FOV: 50 degrees, macula-centered field.
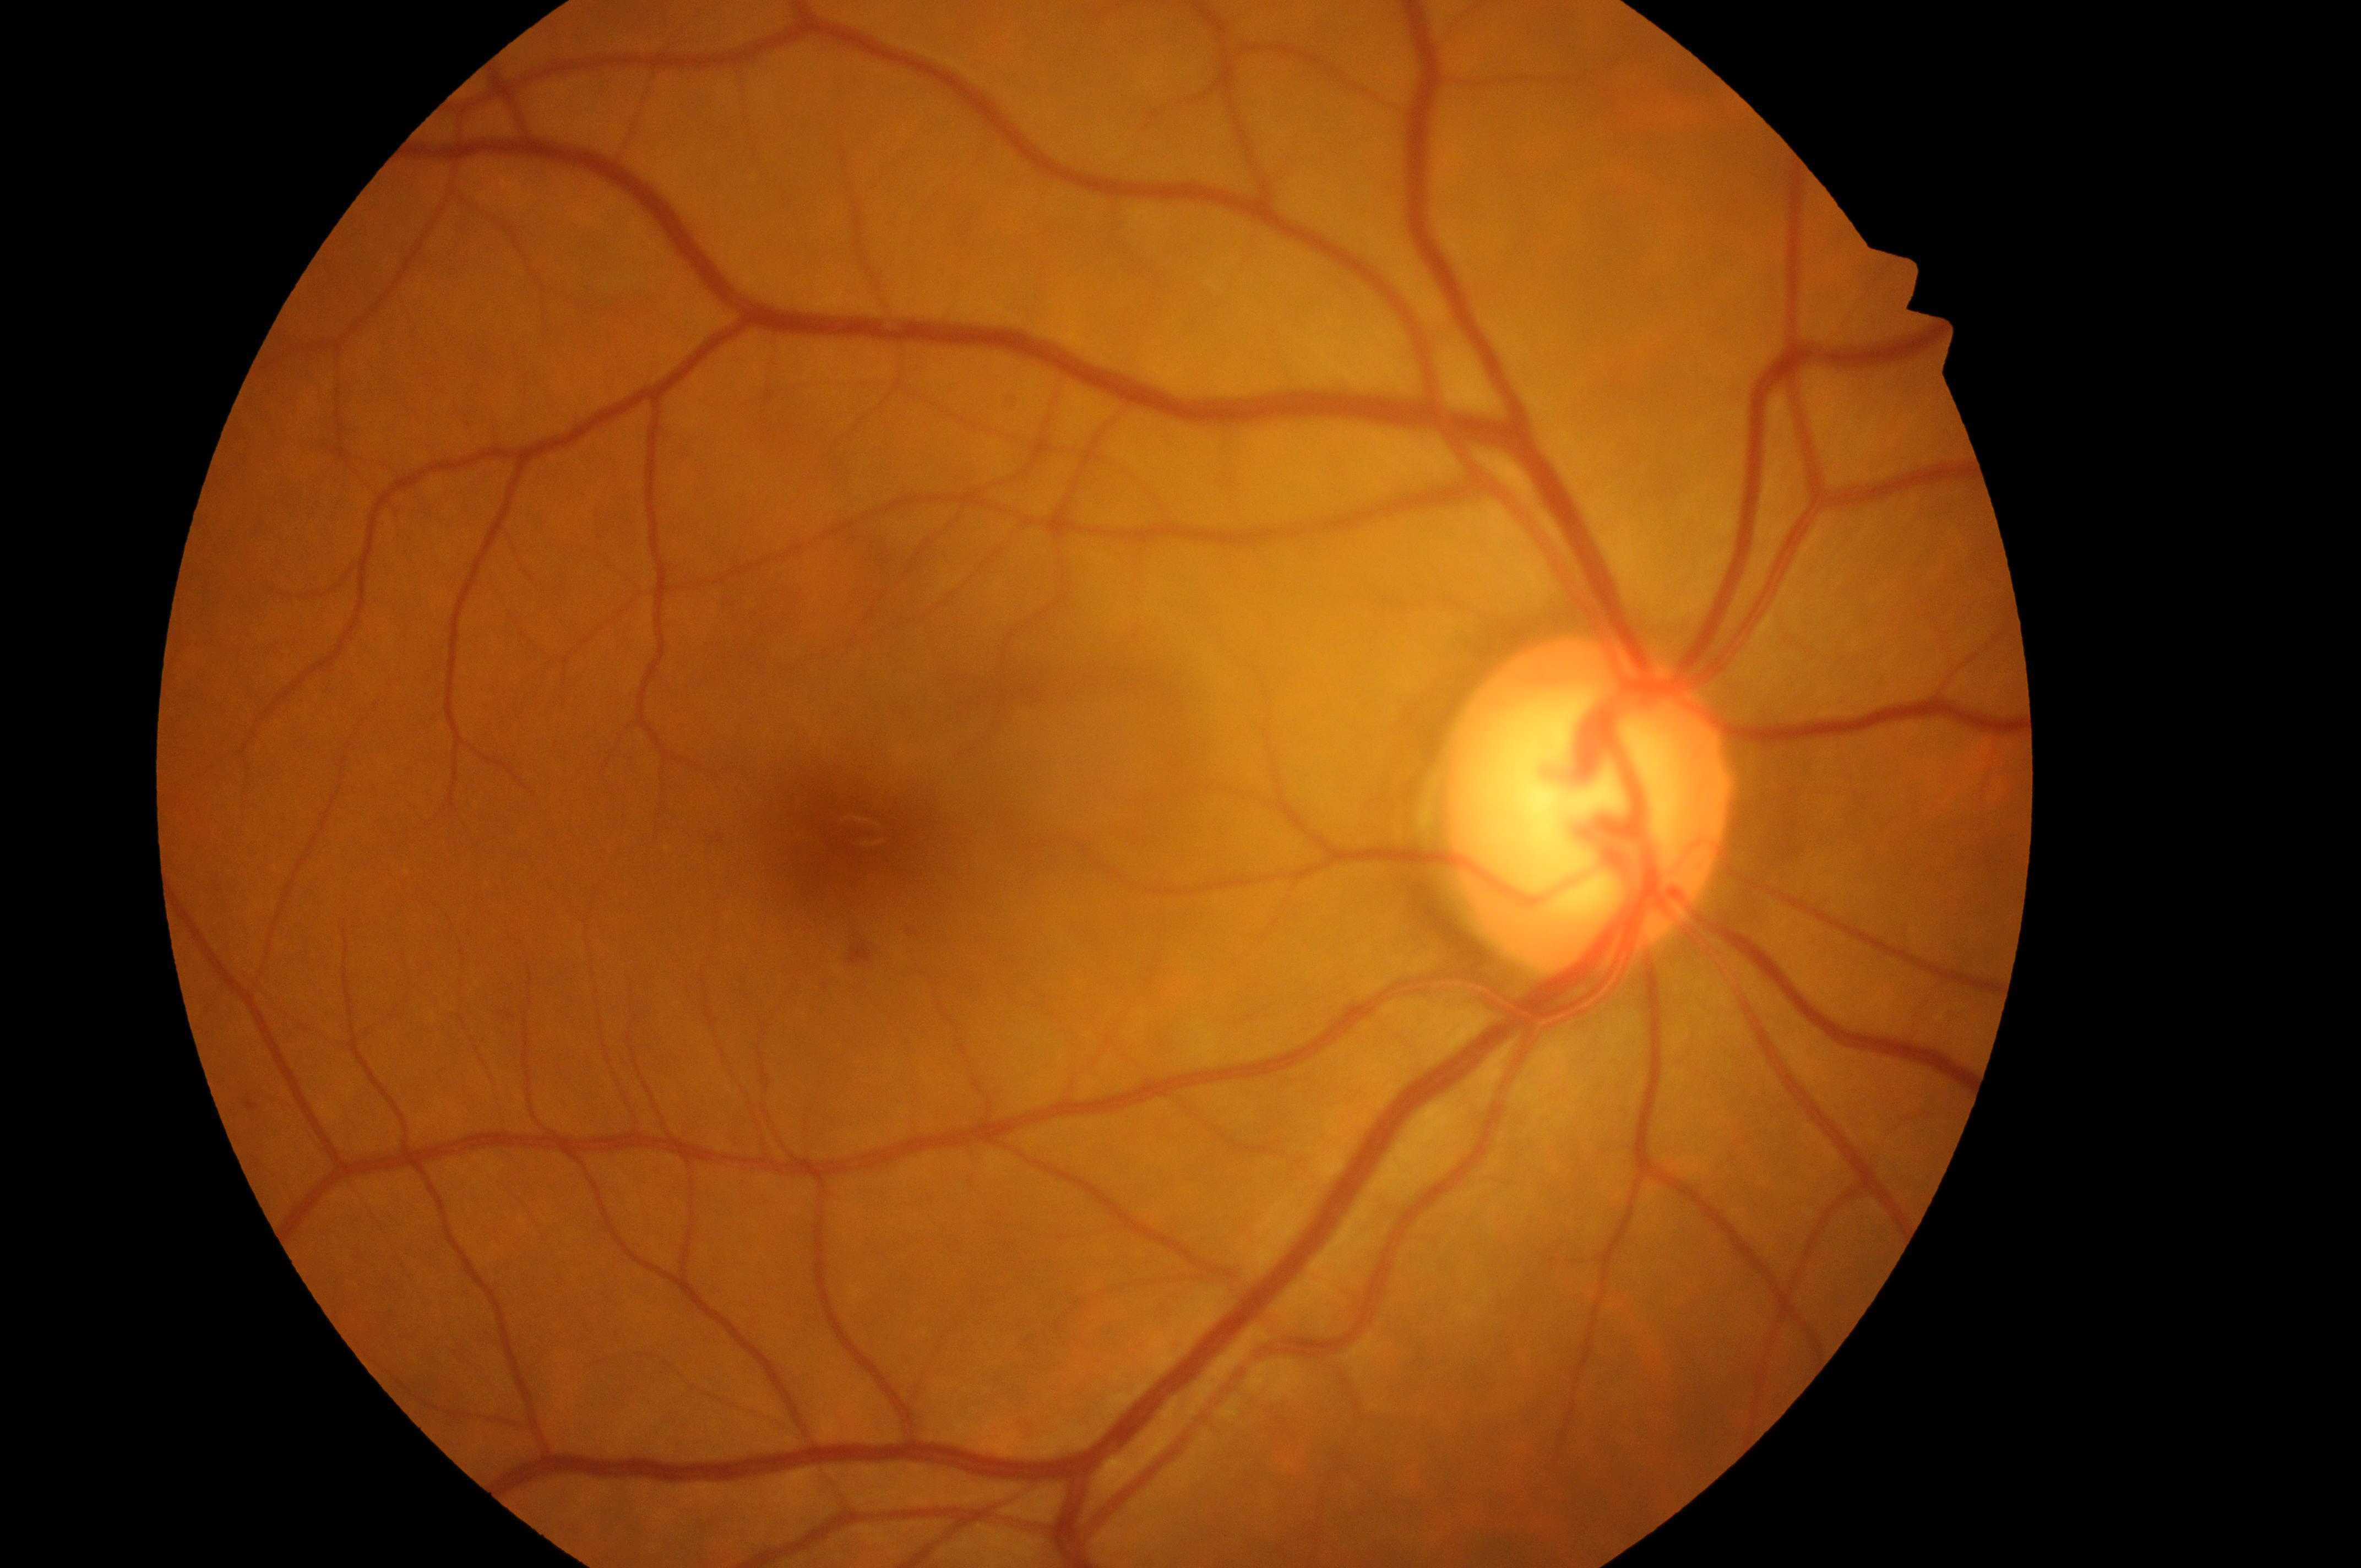
{"dme_grade": "0", "dr_category": "non-proliferative diabetic retinopathy", "optic_disc": "(x=1580, y=818)", "dr_grade": "1", "fovea": "(x=856, y=833)", "eye": "the right eye"}